Macula-centered: 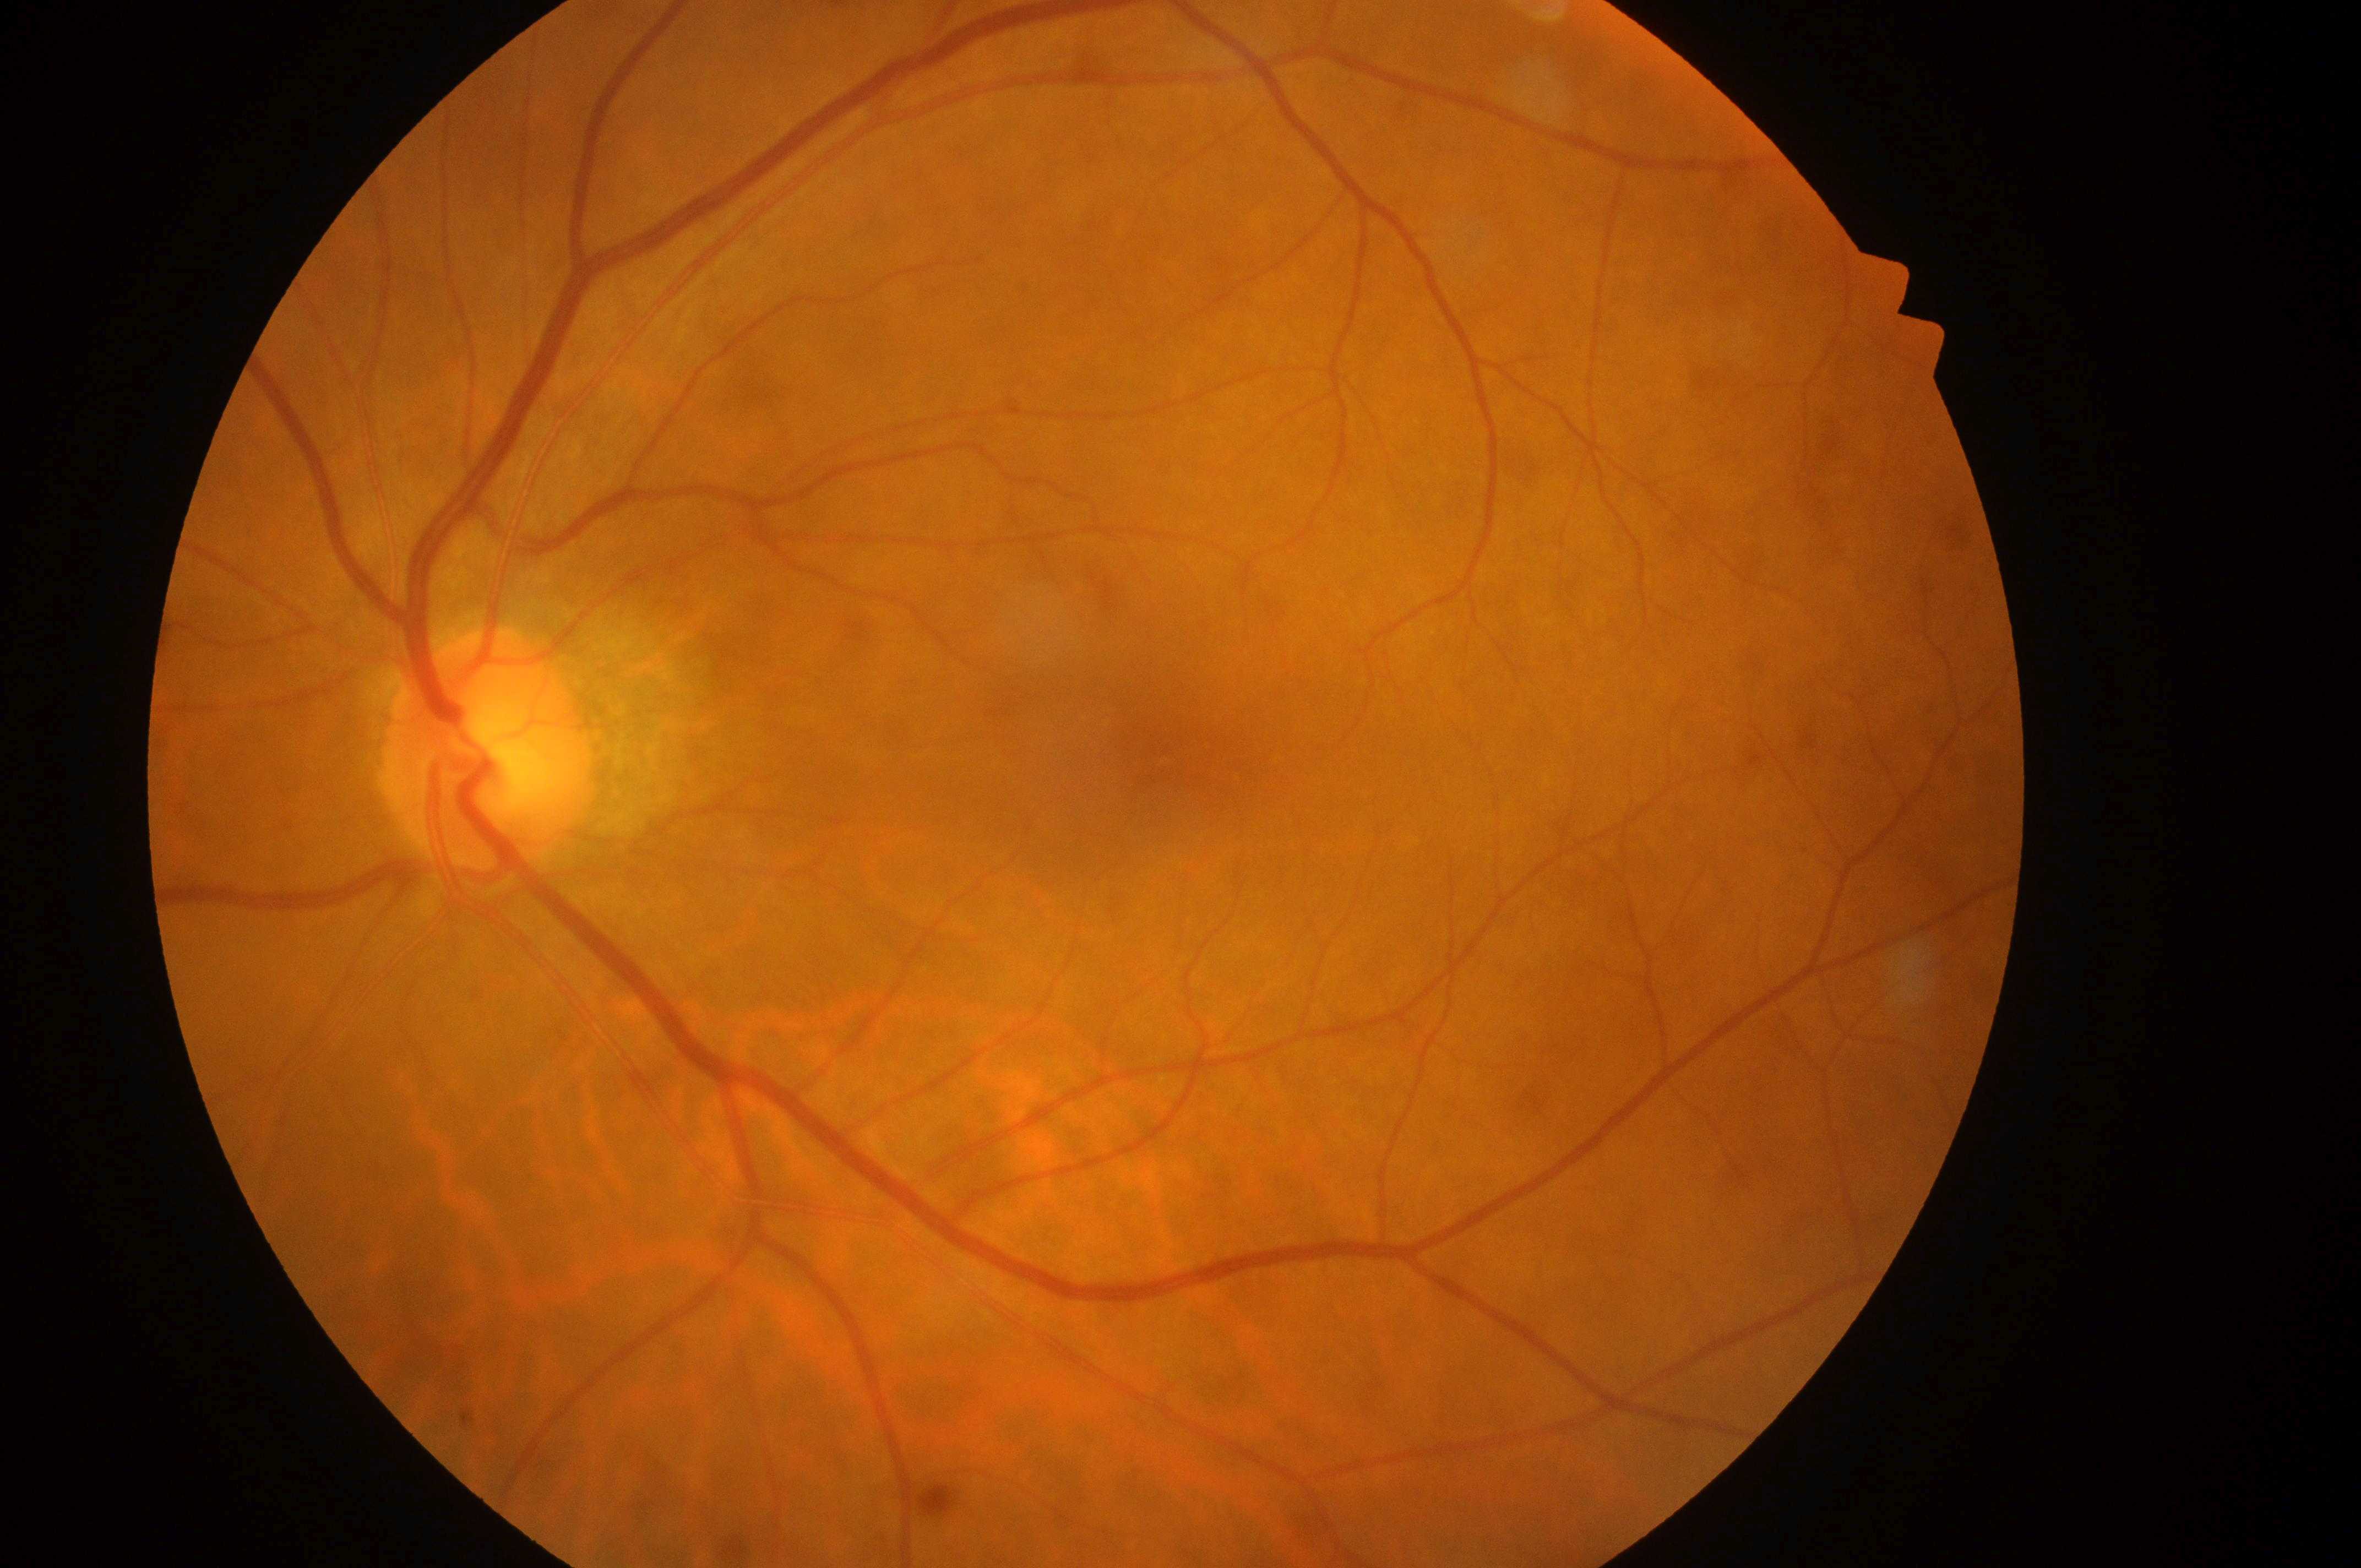 No DR or DME findings; DME risk: grade 0 (no risk) — no apparent hard exudates; the left eye; optic disc: (487,759); DR stage: no apparent diabetic retinopathy (grade 0) — no visible signs of diabetic retinopathy; fovea: (1167,746).